Image size 2346x1568 · color fundus photograph:
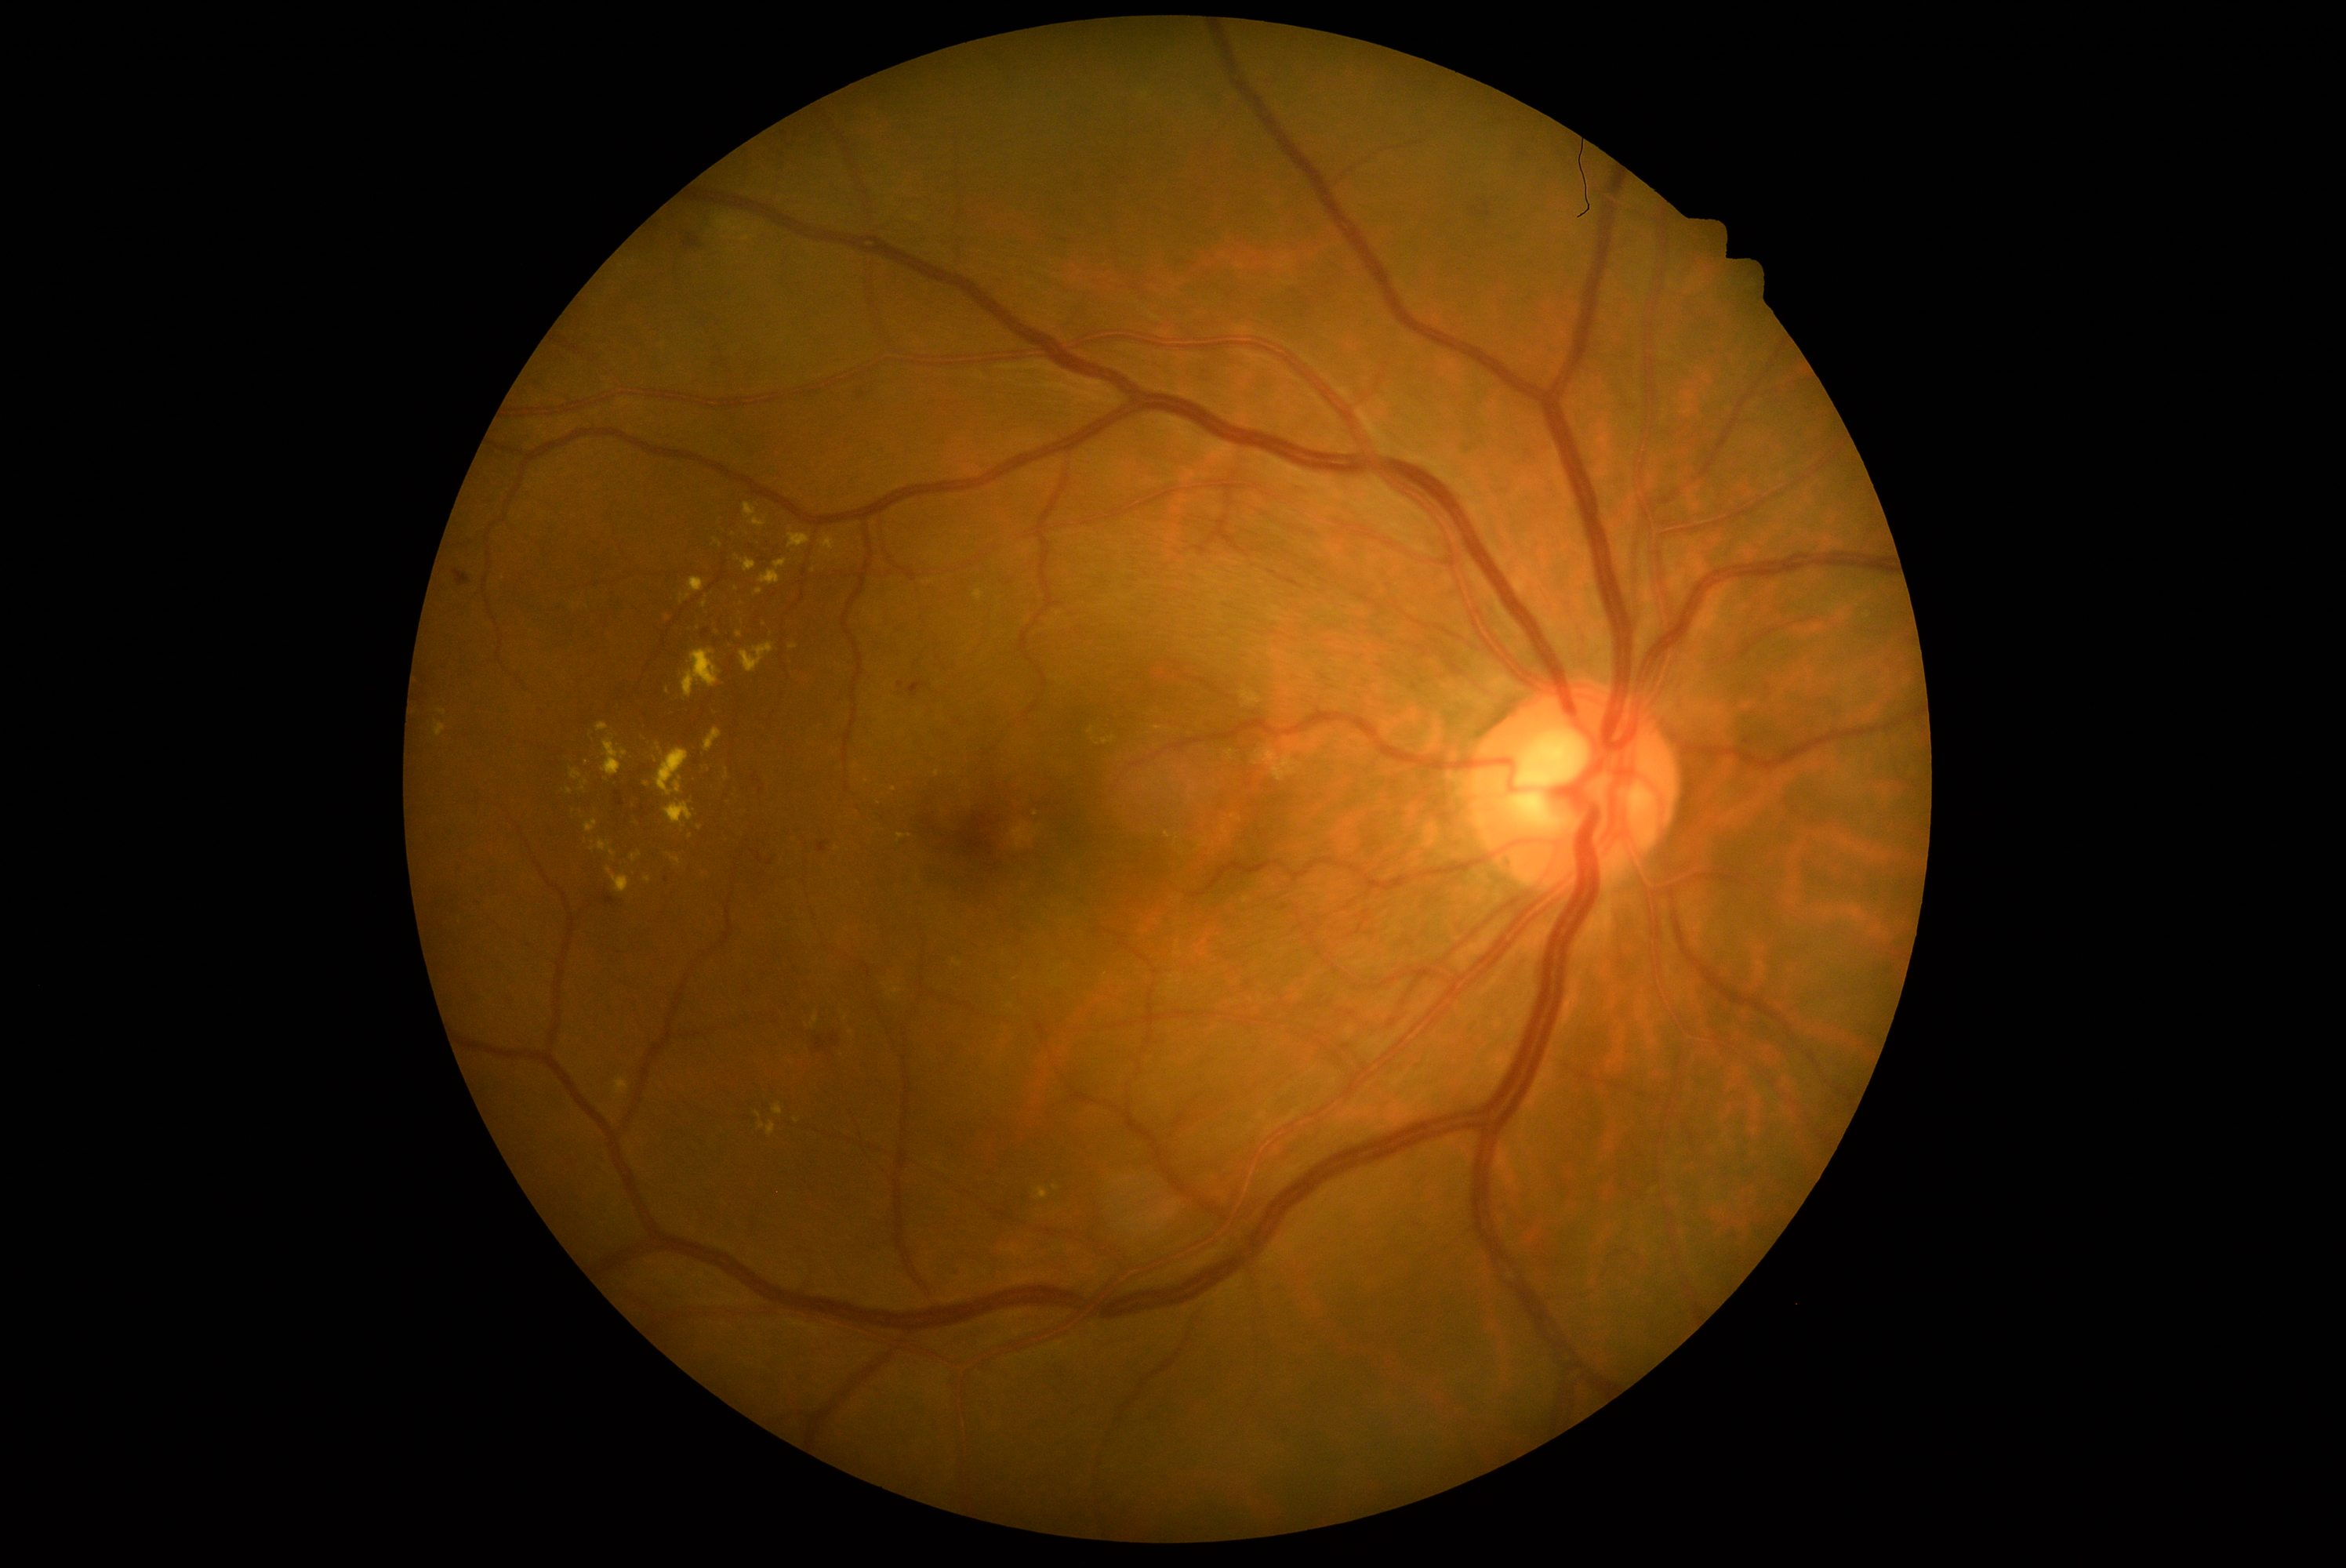

DR grade is 2
Lesions identified (partial list):
EXs (continued): <box>788,534,810,548</box> | <box>648,739,658,753</box> | <box>584,821,598,833</box> | <box>724,644,732,652</box> | <box>724,769,728,780</box> | <box>700,763,710,772</box> | <box>755,589,763,595</box> | <box>608,868,631,893</box> | <box>739,642,774,672</box> | <box>628,797,636,811</box>
Small EXs near x=592 y=850 | x=736 y=591 | x=716 y=634 | x=613 y=854 | x=690 y=836